Graded on the modified Davis scale; nonmydriatic fundus photograph:
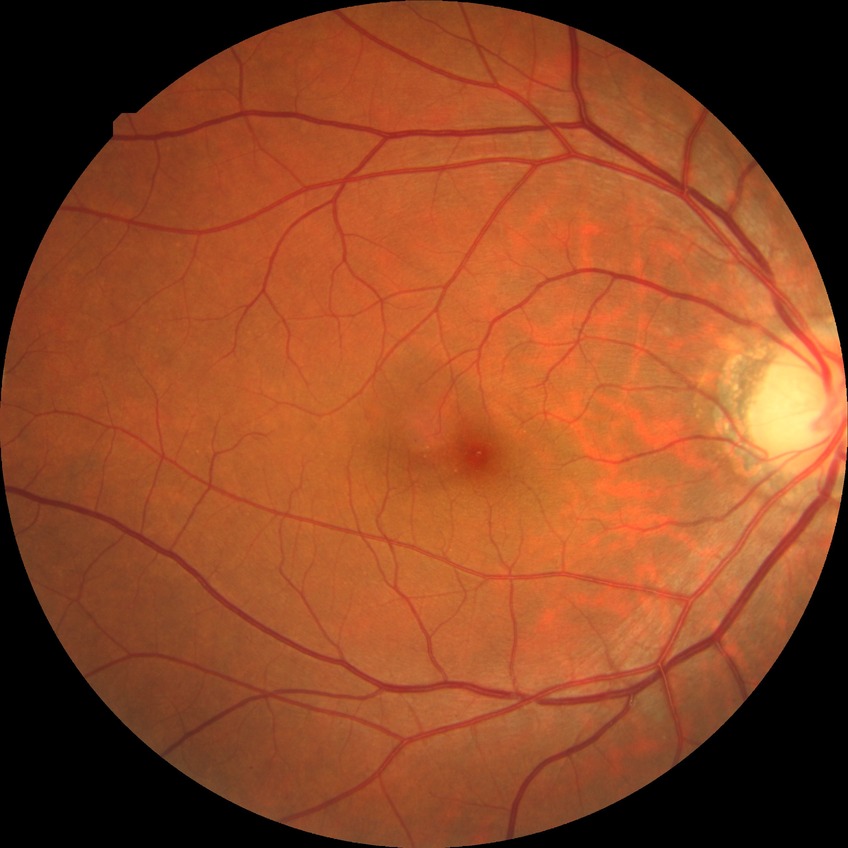

Modified Davis grading: no diabetic retinopathy.